Nidek AFC-330, CFP.
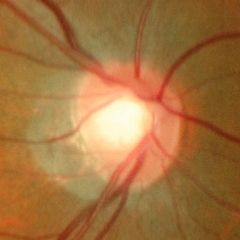
Findings consistent with glaucoma.
Early glaucomatous optic neuropathy.
Diagnostic criteria: glaucomatous retinal nerve fiber layer defects on red-free fundus photography without visual field defects.